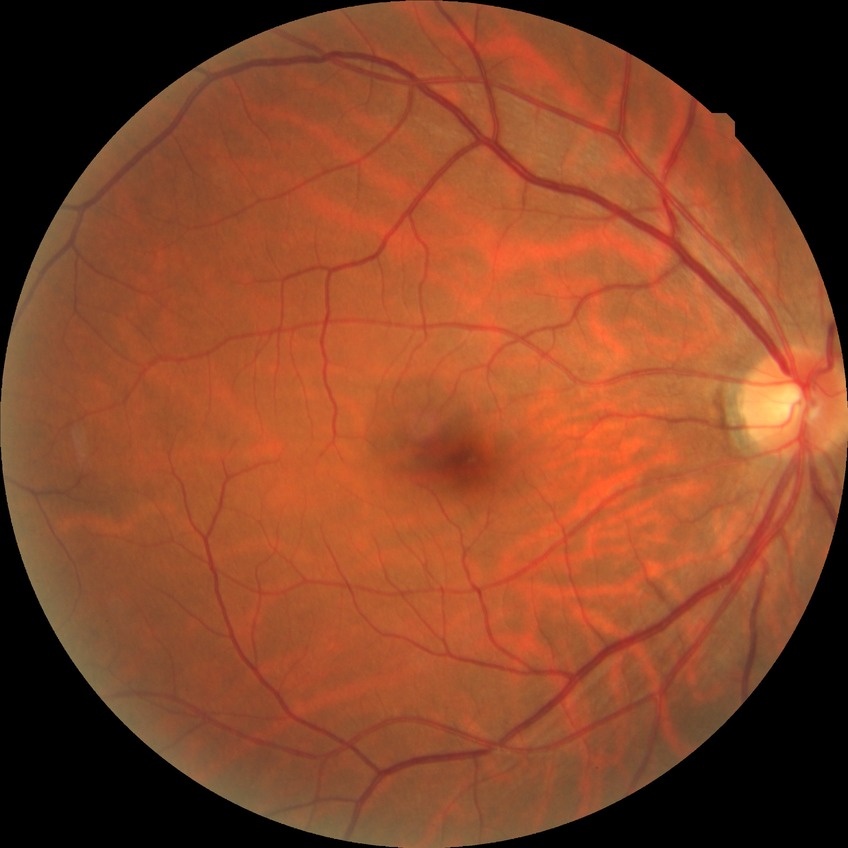
davis_grade: NDR (no diabetic retinopathy)